45-degree field of view. Color fundus image:
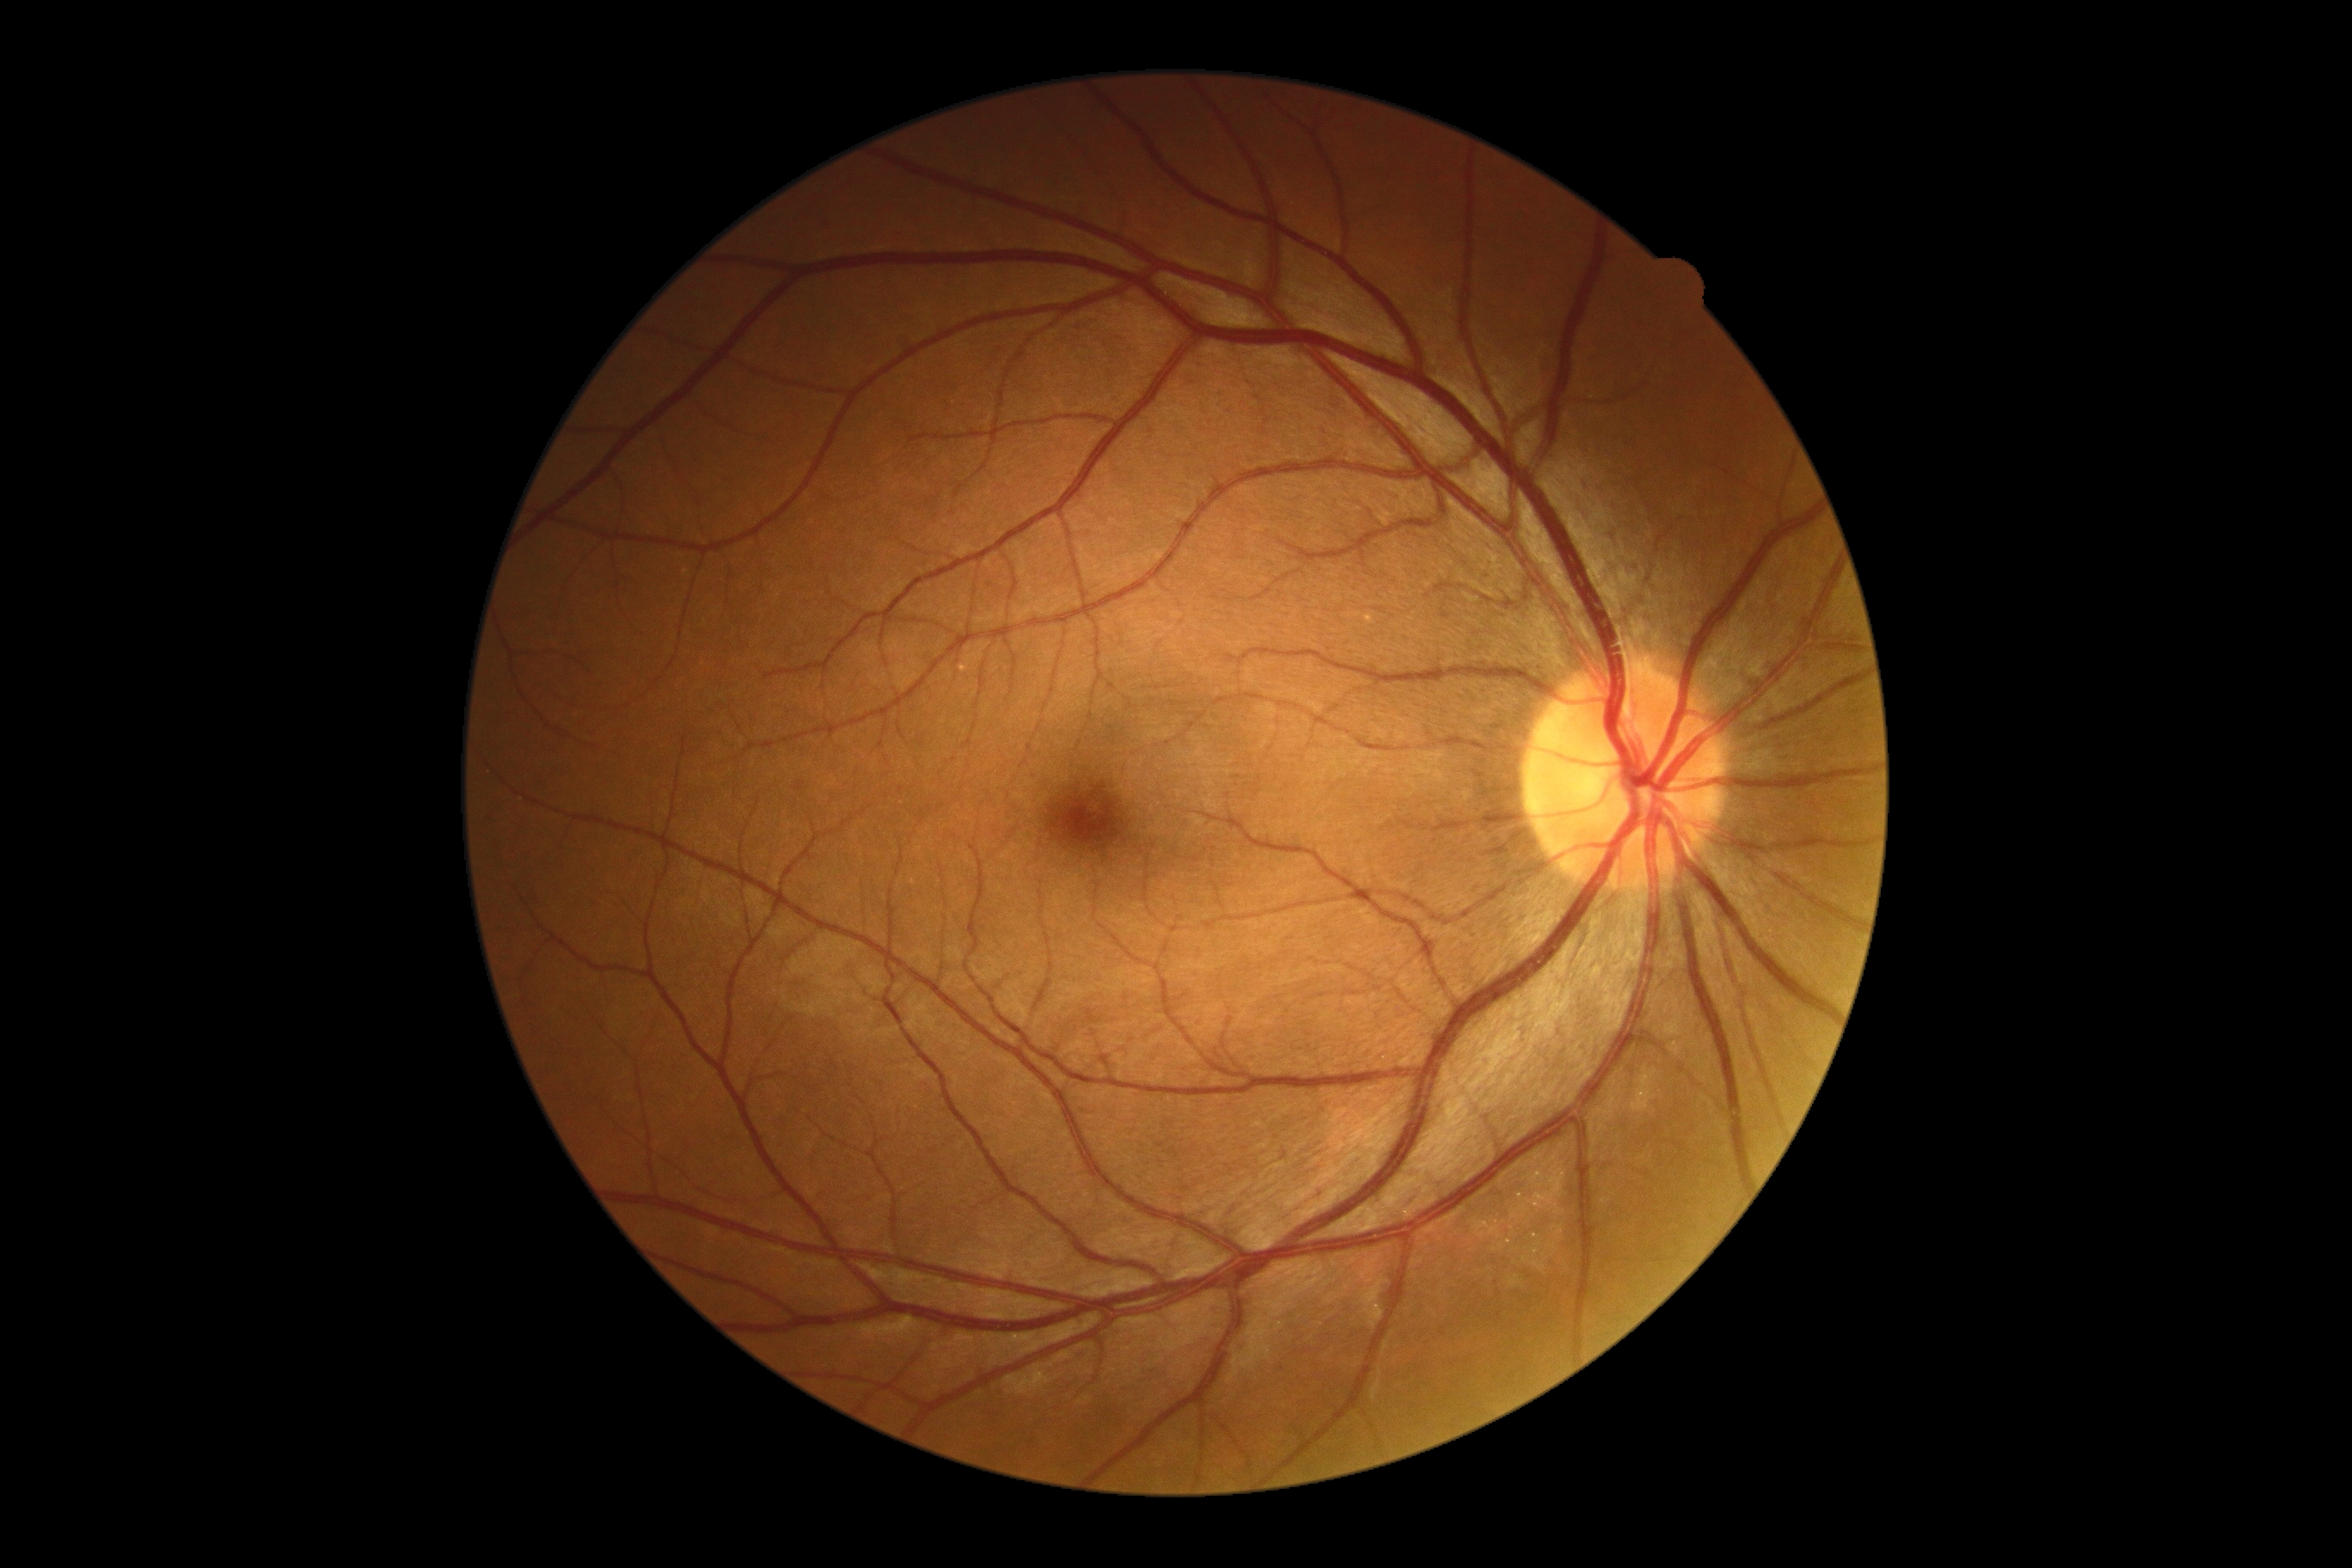

DR: 0.